45° field of view: 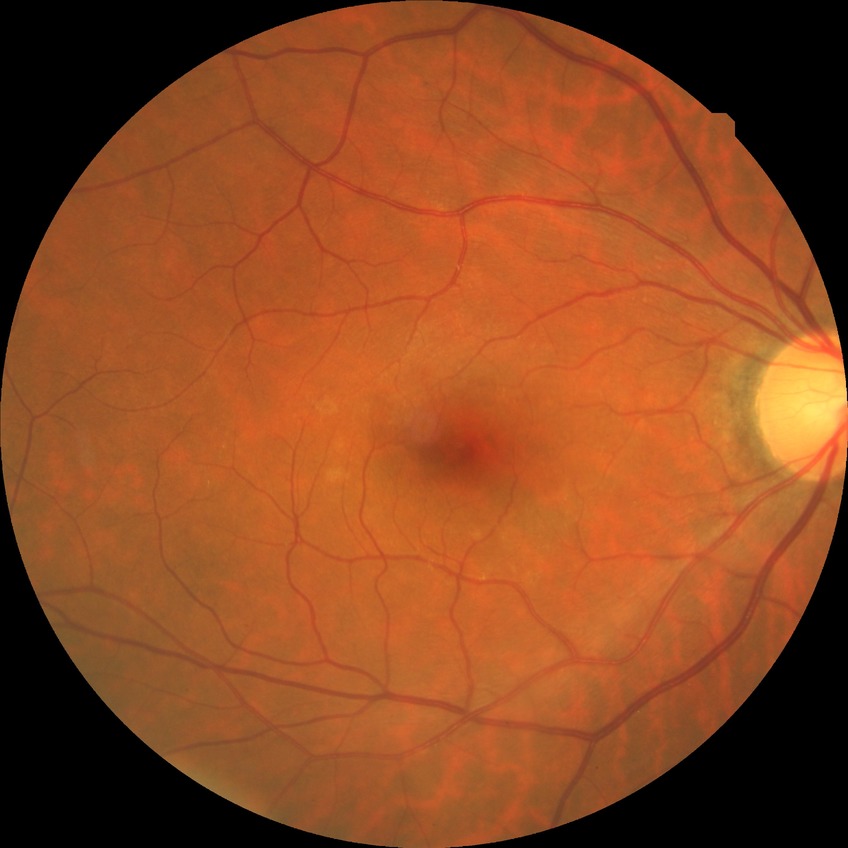

Retinopathy stage: no diabetic retinopathy.